Image size 2352x1568: 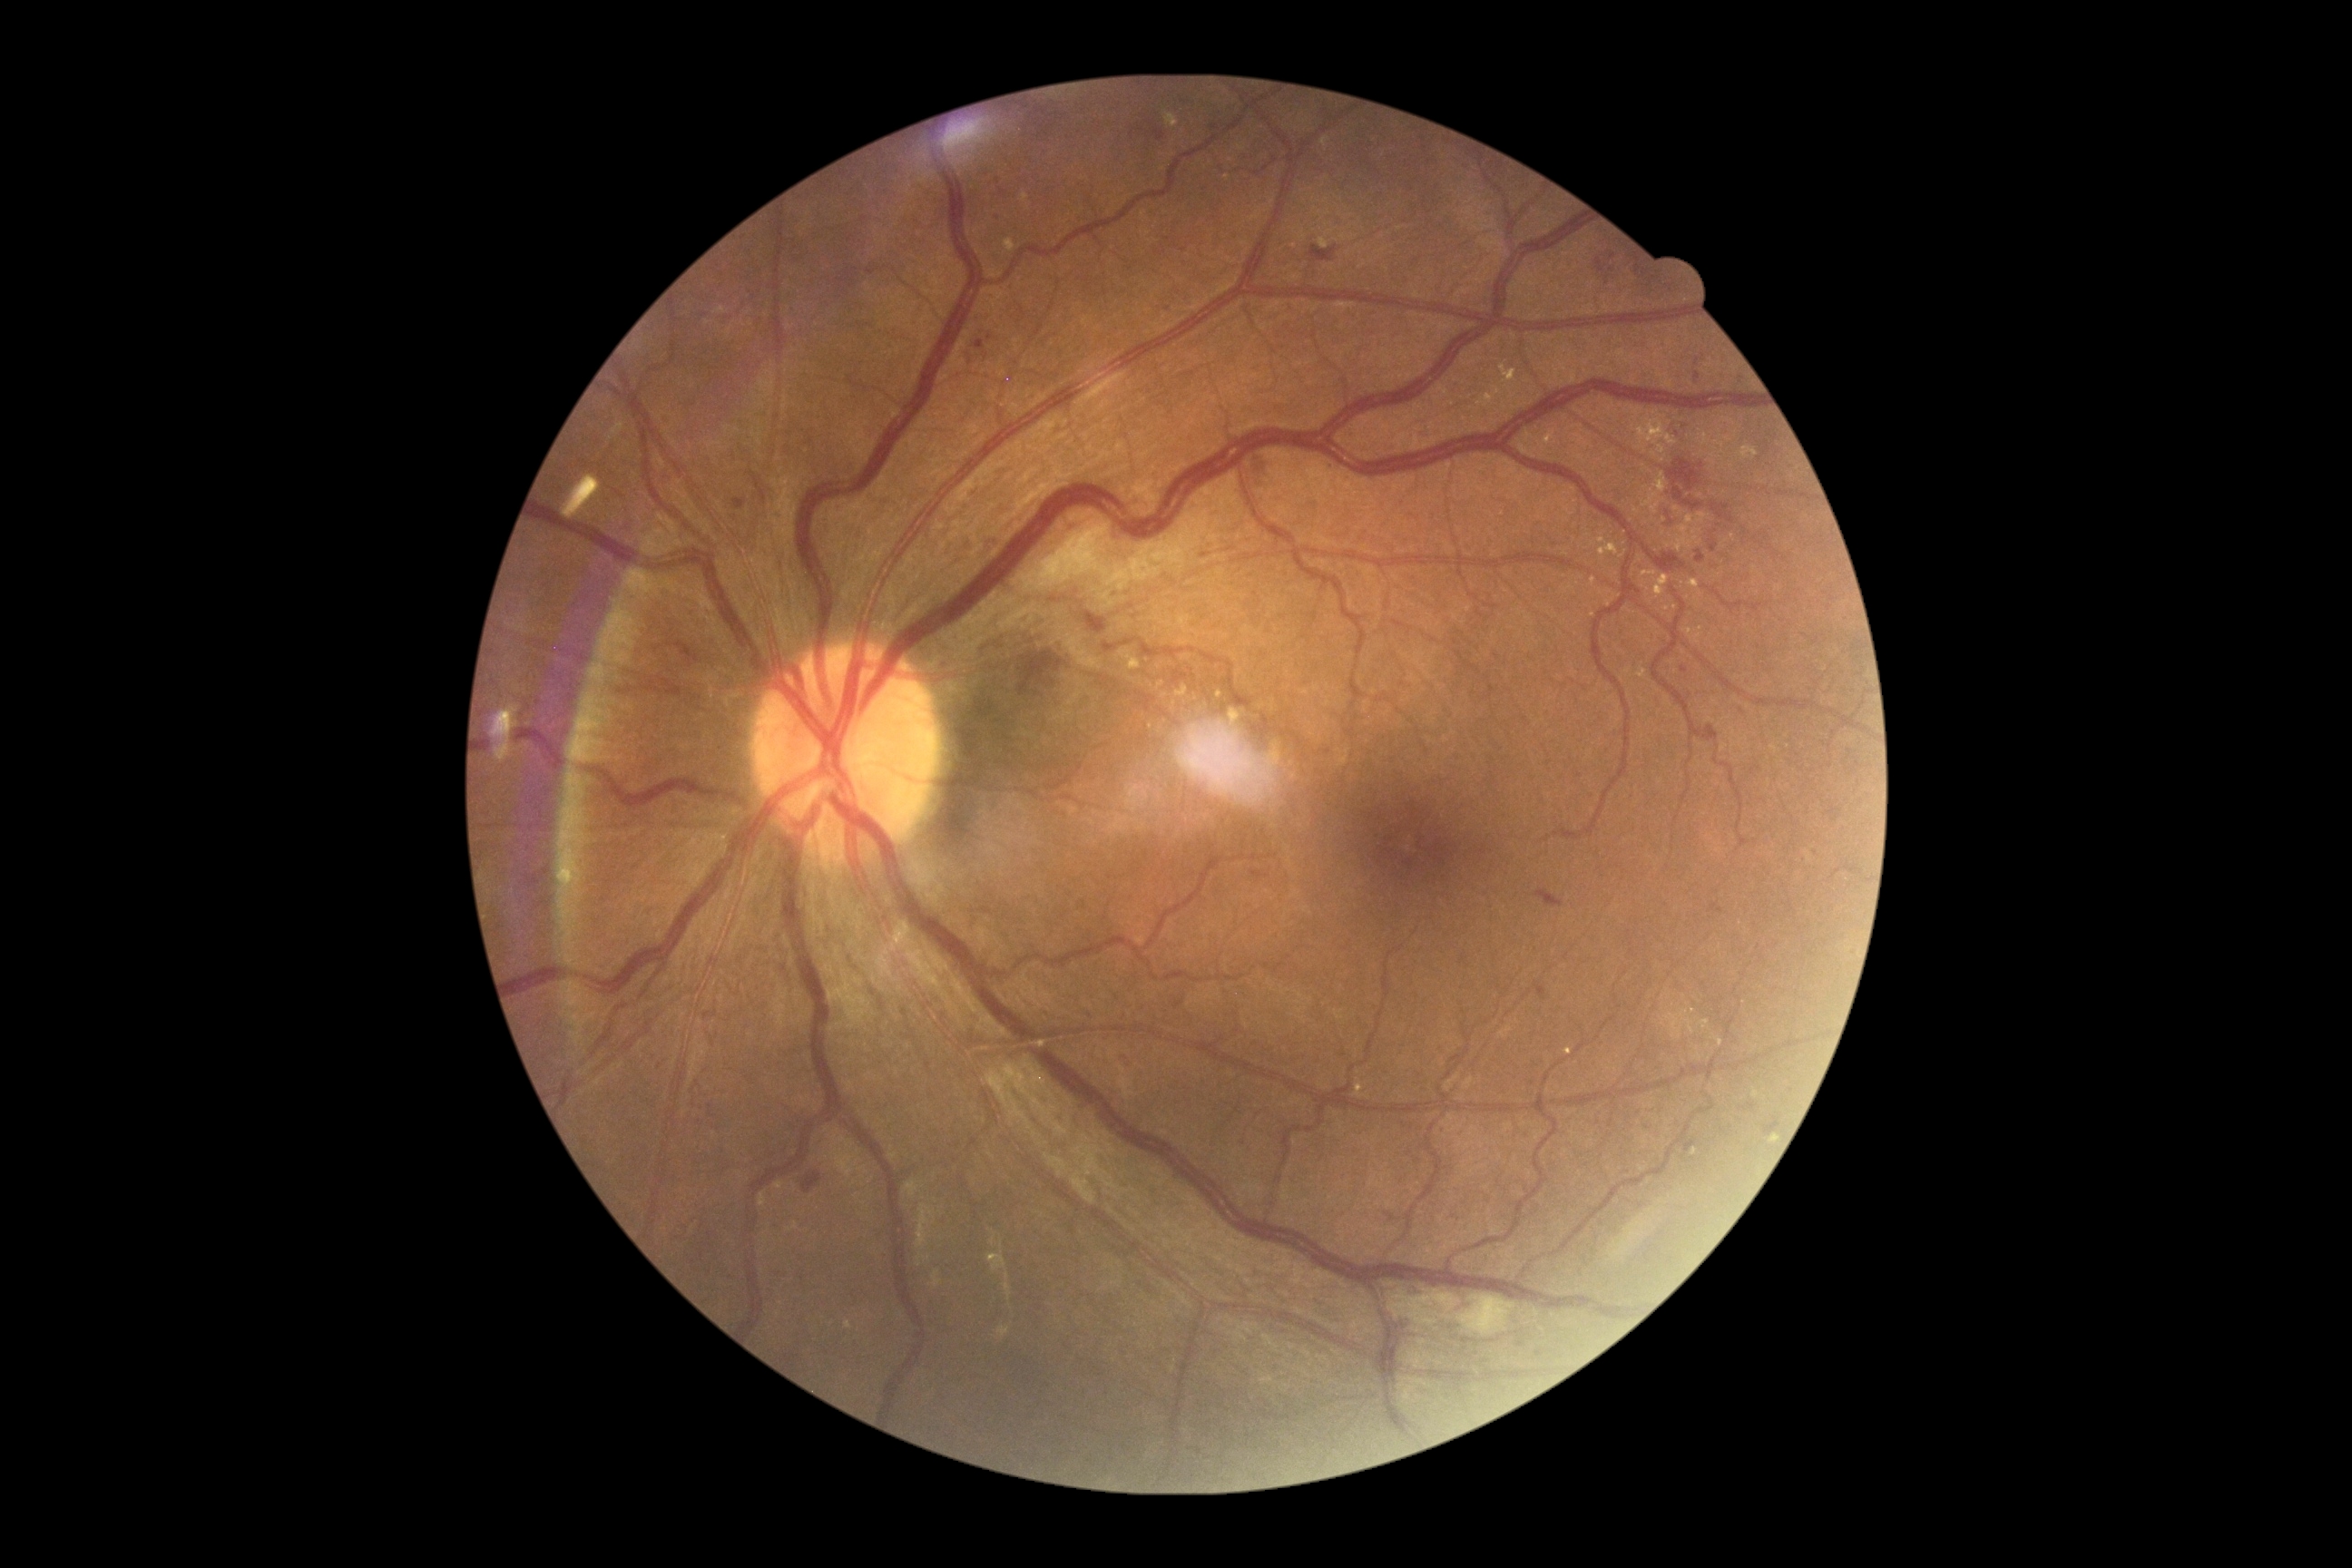 dr_grade: 2